Wide-field contact fundus photograph of an infant · 1240 x 1240 pixels · Phoenix ICON, 100° FOV:
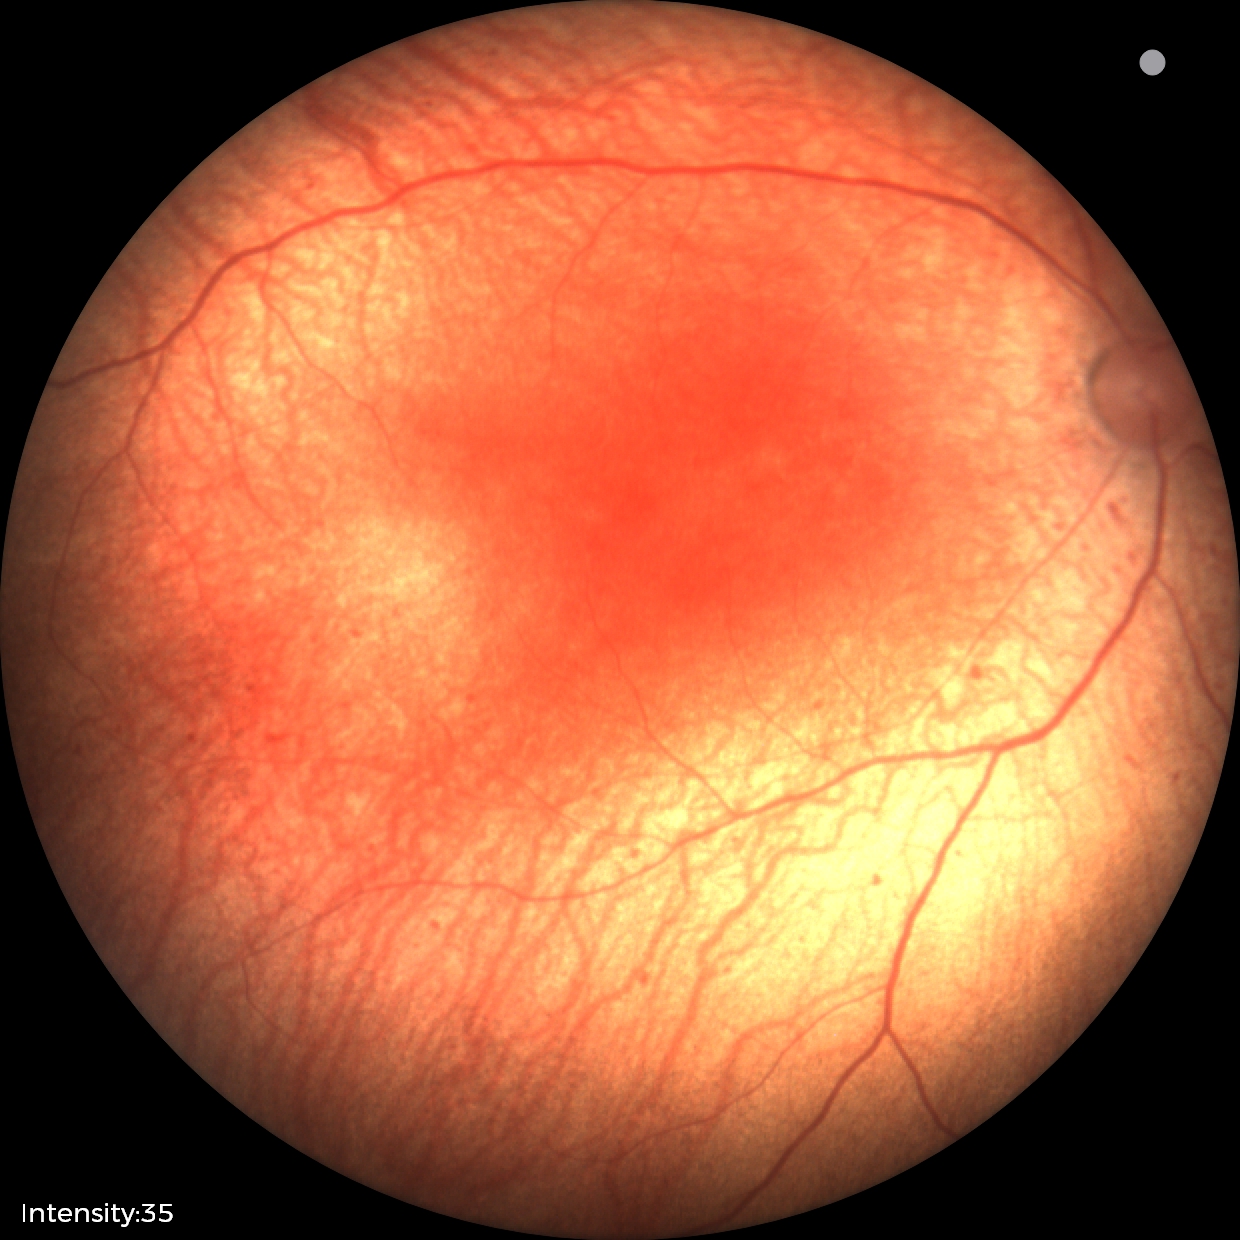
Screening diagnosis: no plus disease; status post ROP.